NIDEK AFC-230 fundus camera · 45° FOV · nonmydriatic fundus photograph · retinal fundus photograph — 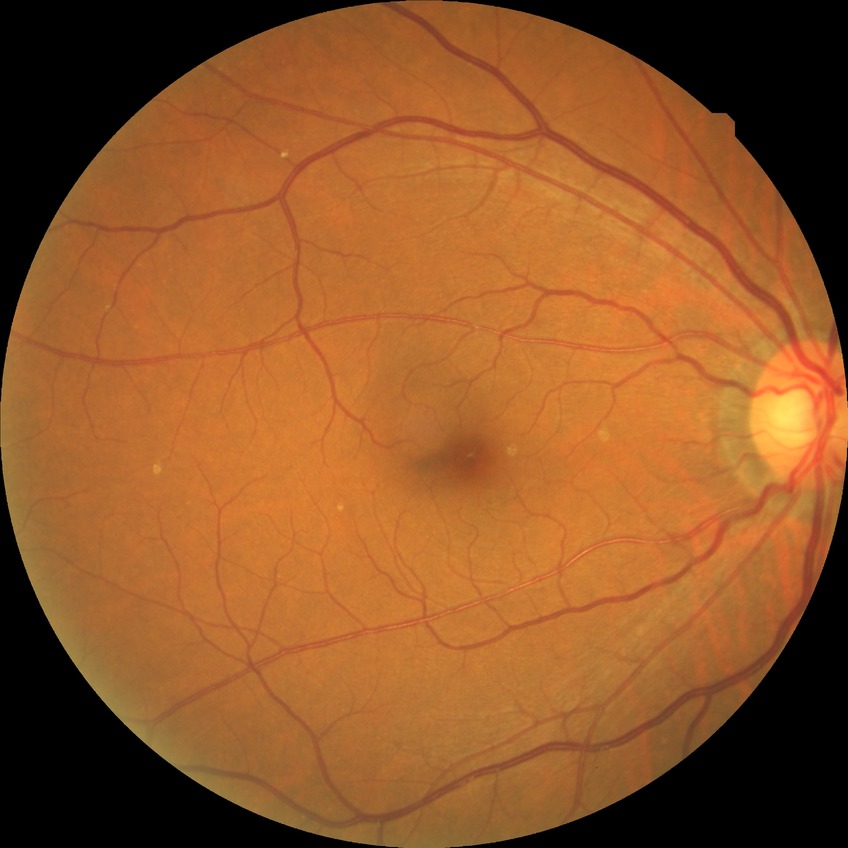

diabetic retinopathy (DR): no diabetic retinopathy (NDR).